Captured after pupil dilation; 2228x1652: 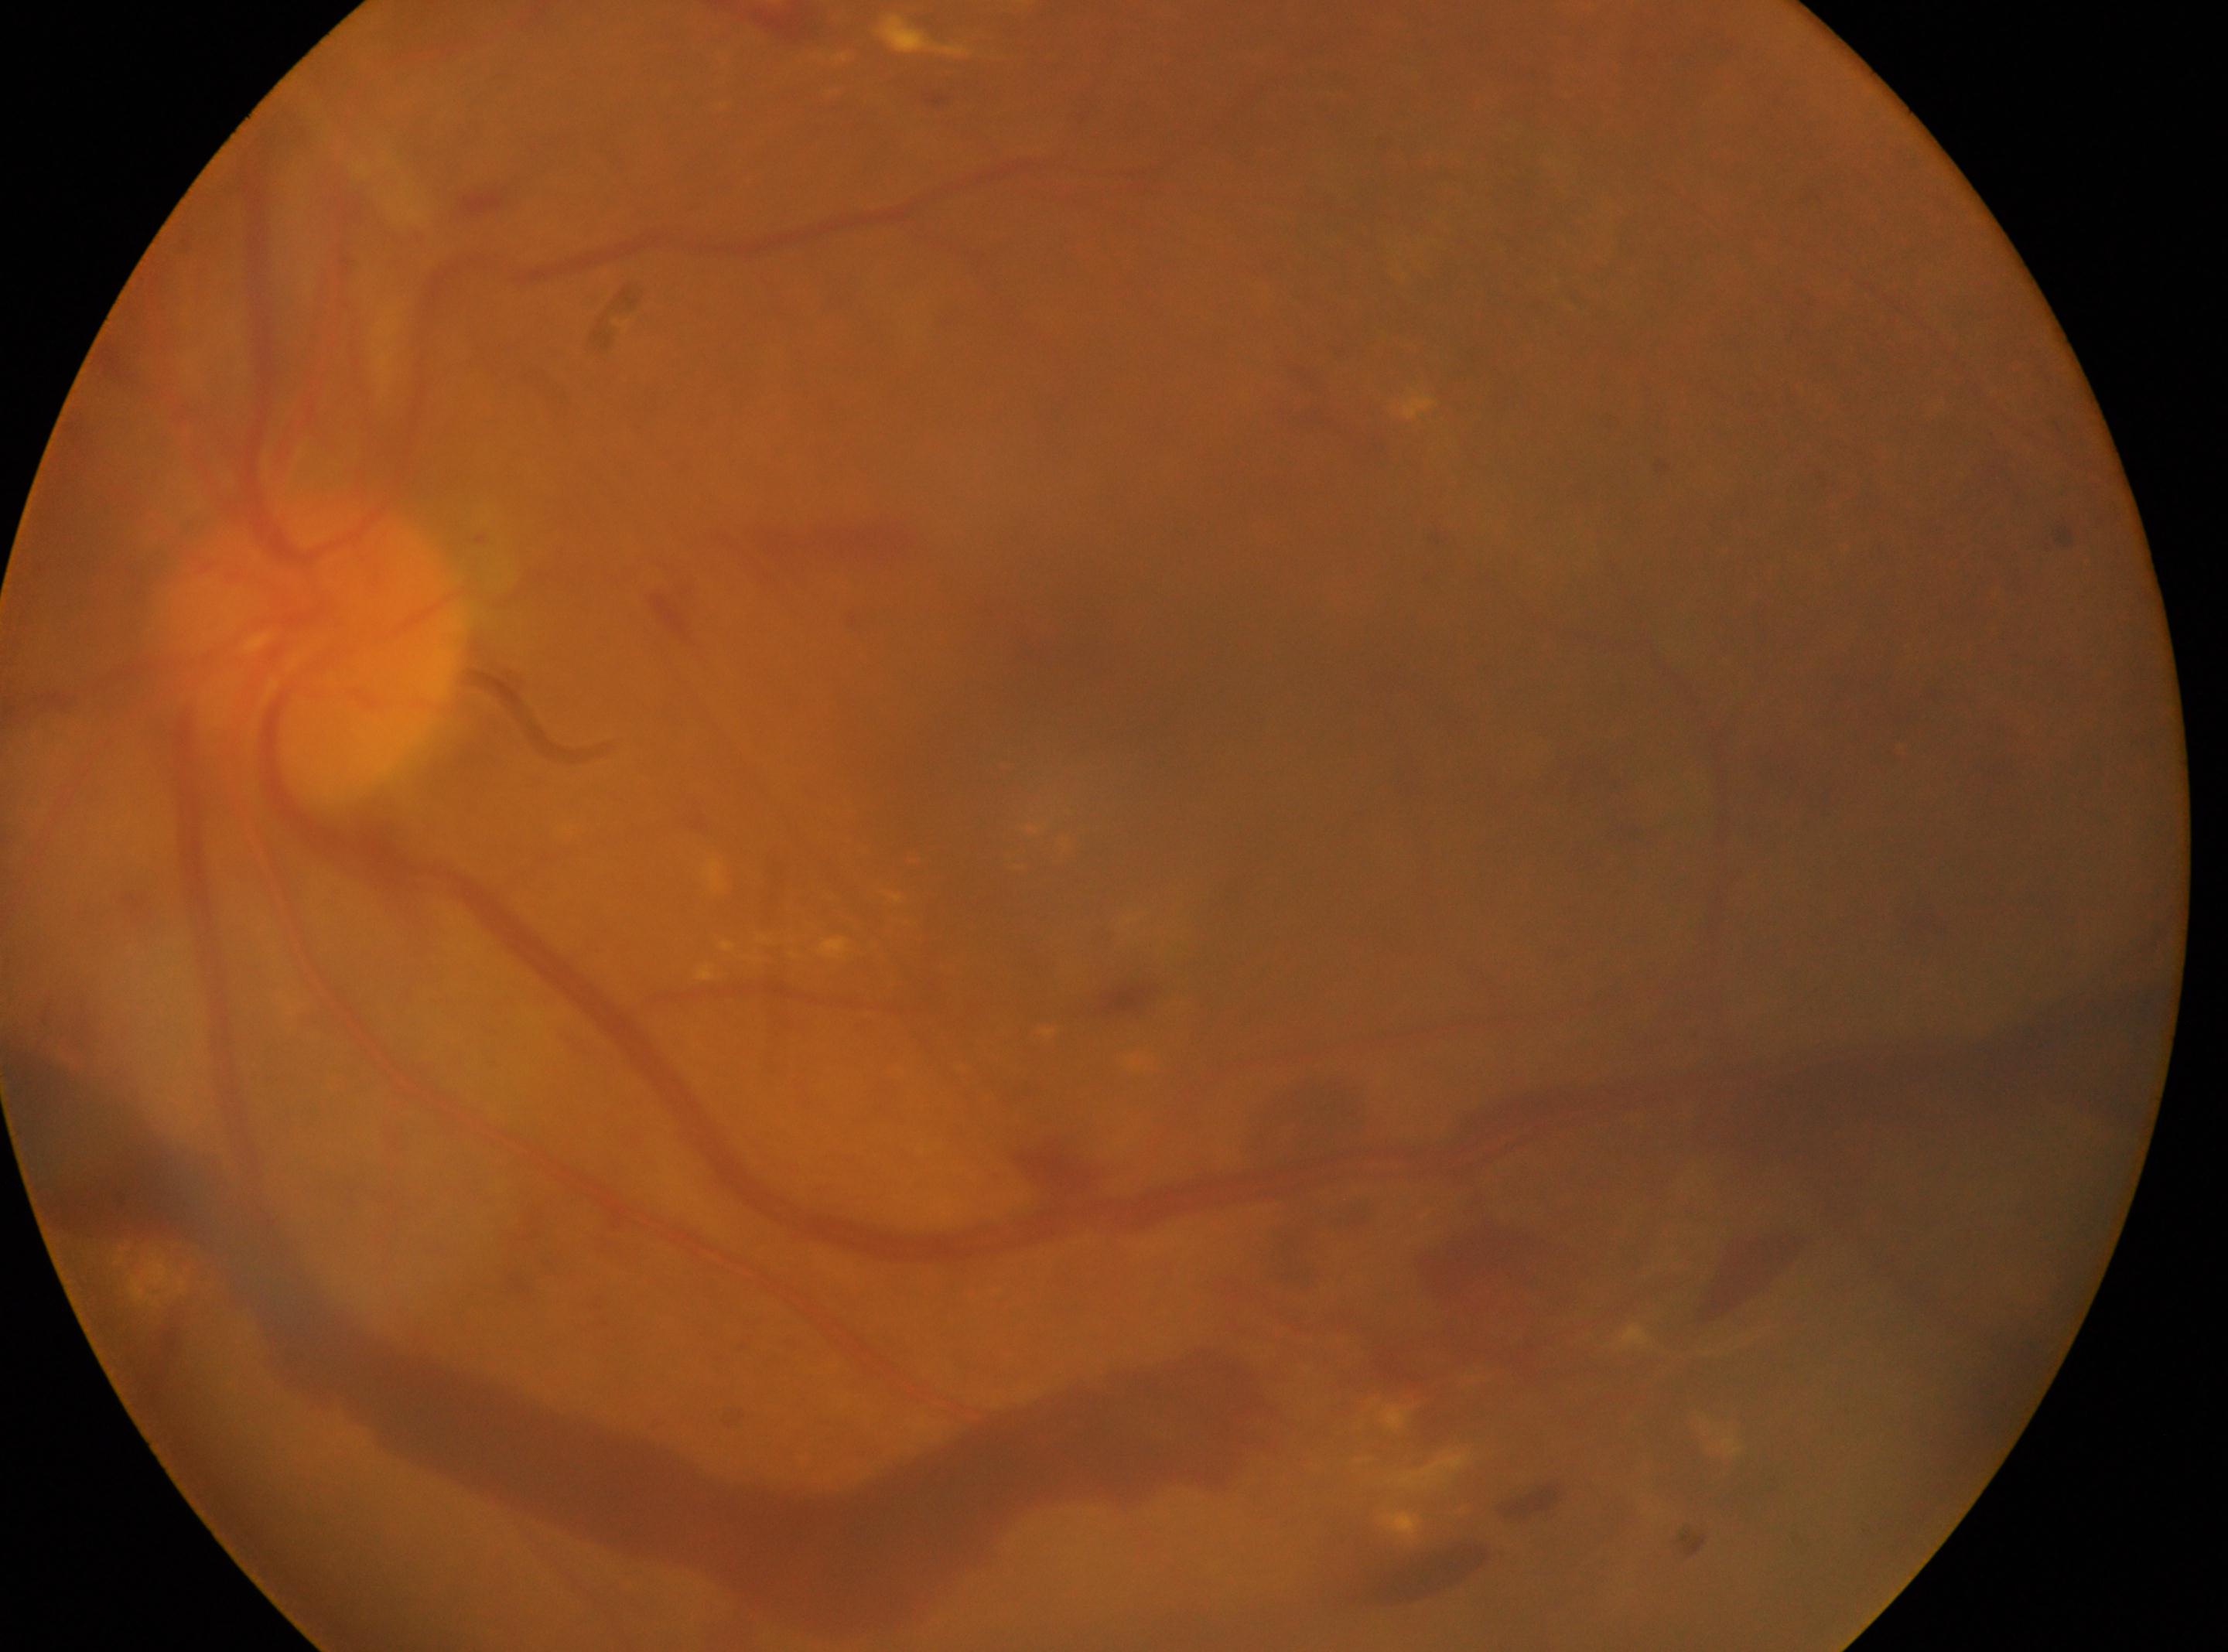
Annotations:
• fovea centralis · (1068, 636)
• optic disc center · (313, 648)
• laterality · left eye
• retinopathy · 4/4
• DR class · proliferative diabetic retinopathy